DR severity per modified Davis staging, 848 x 848 pixels:
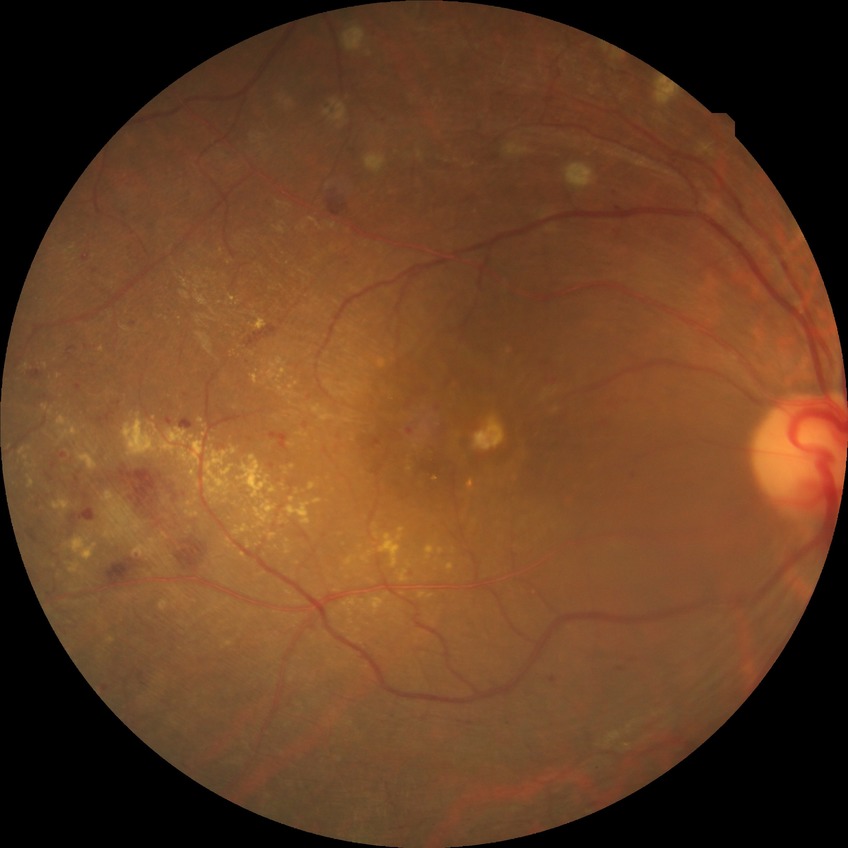

diabetic retinopathy severity = proliferative diabetic retinopathy.